DR severity per modified Davis staging, posterior pole color fundus photograph:
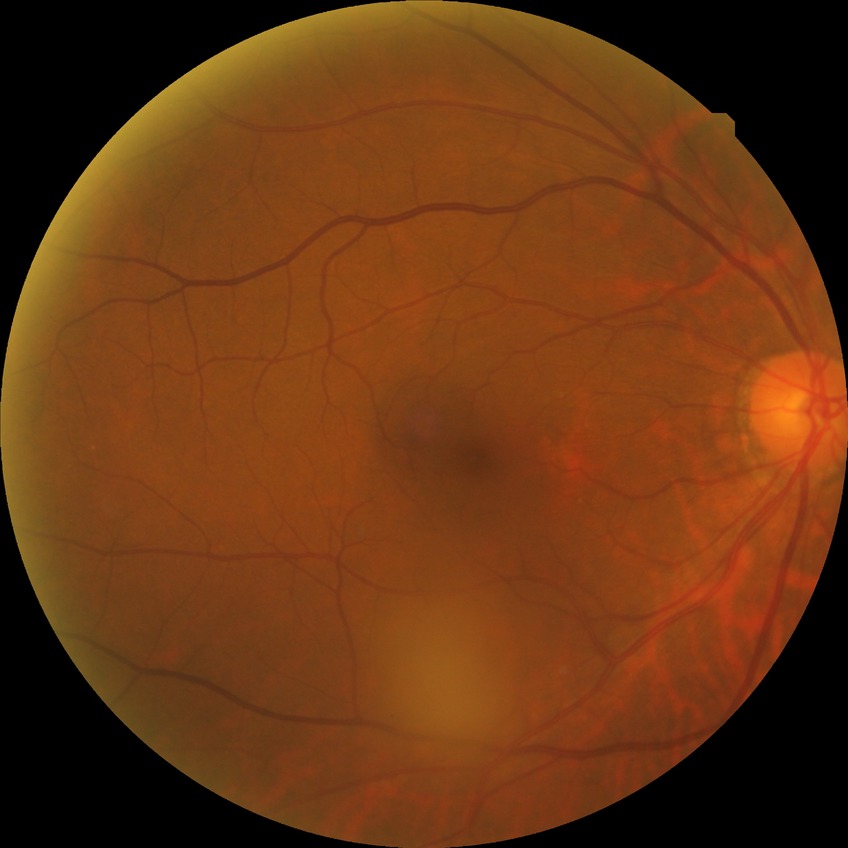 Annotations:
– DR impression: no signs of DR
– DR grade: NDR